Image size 640x480. Pediatric wide-field fundus photograph — 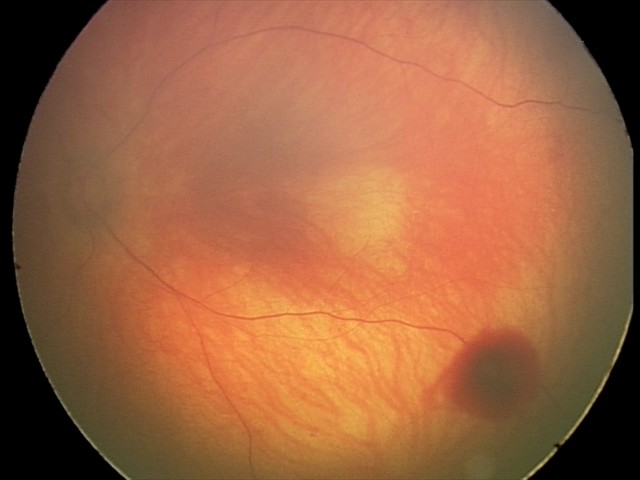 Q: What is the diagnosis from this examination?
A: retinal hemorrhages